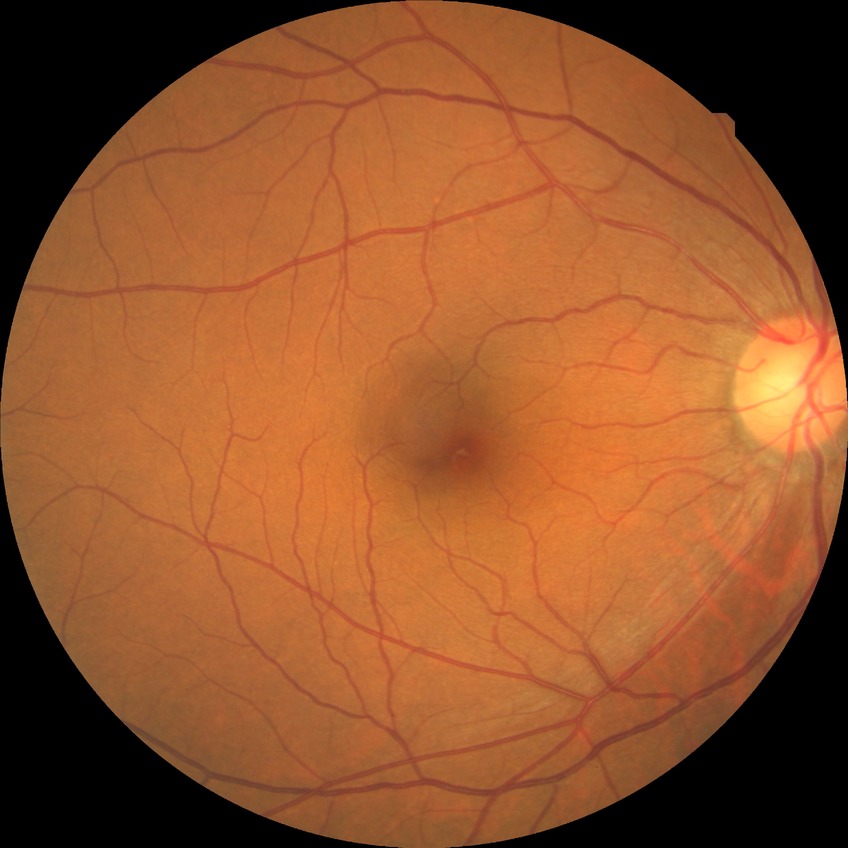 davis_grade: no diabetic retinopathy